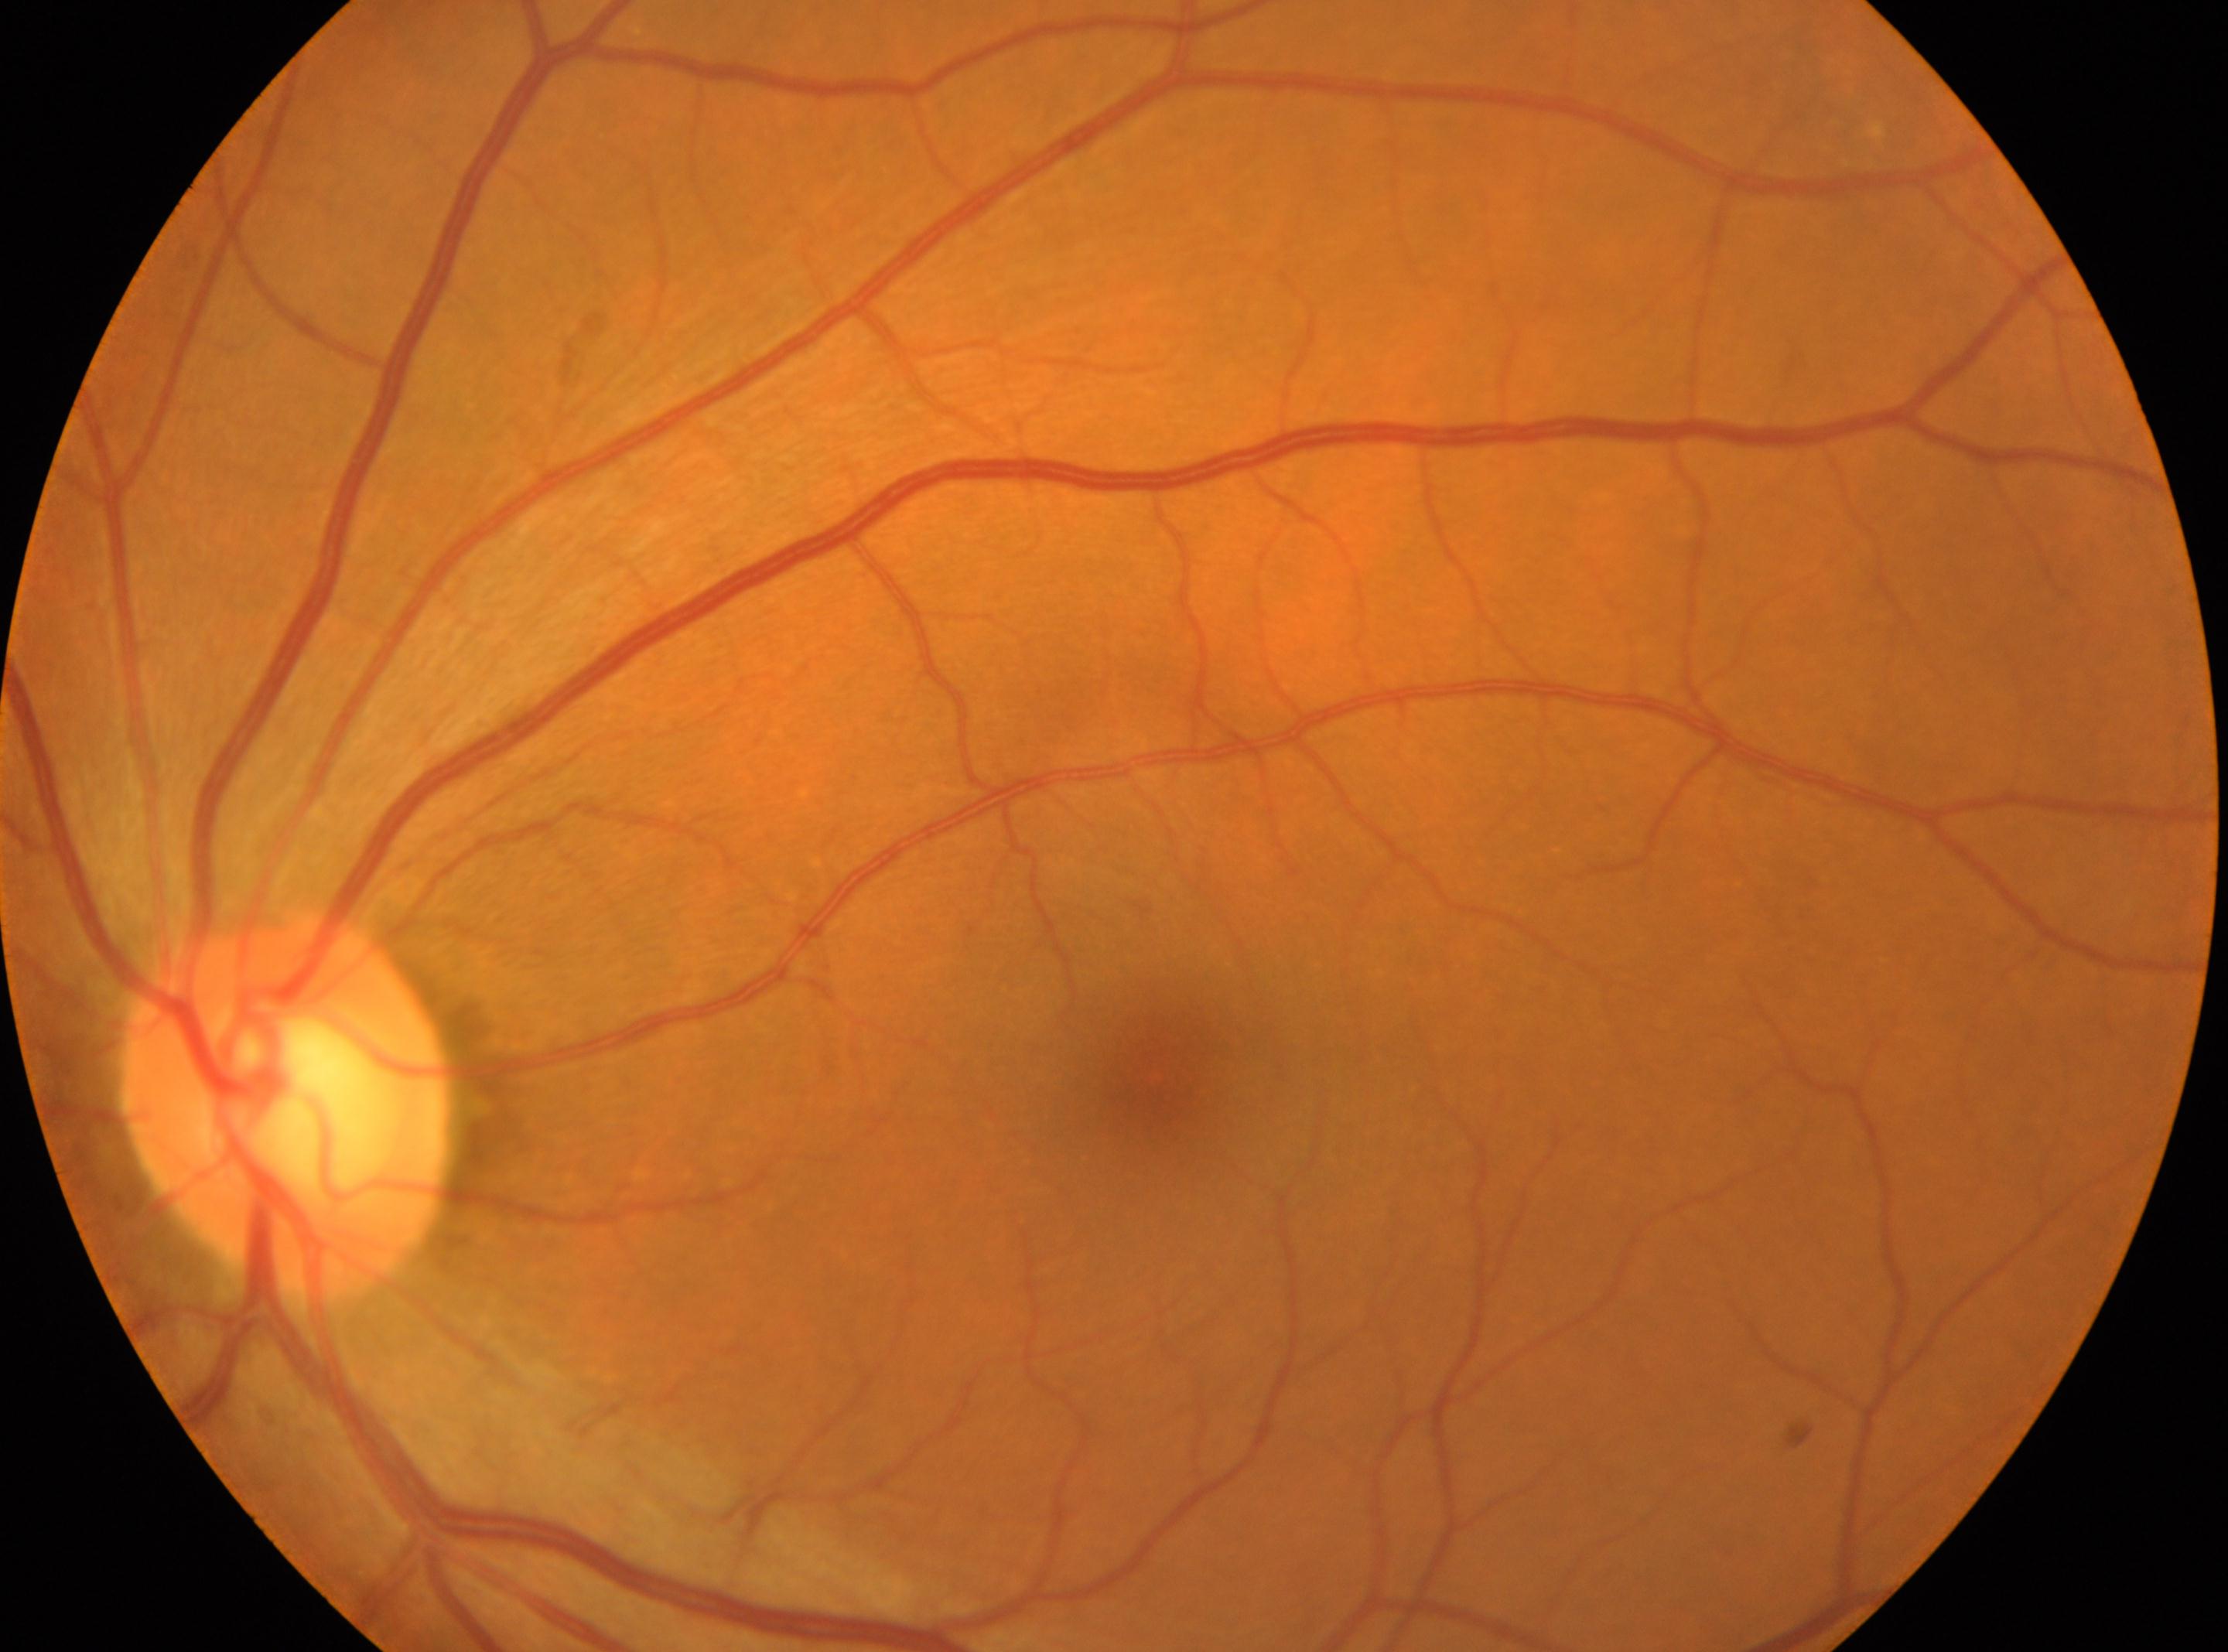
{
  "dr_grade": "0",
  "optic_disc": "[285, 1109]",
  "eye": "oculus sinister",
  "fovea": "[1156, 1075]"
}